Phoenix ICON wide-field infant fundus image; 1240 x 1240 pixels: 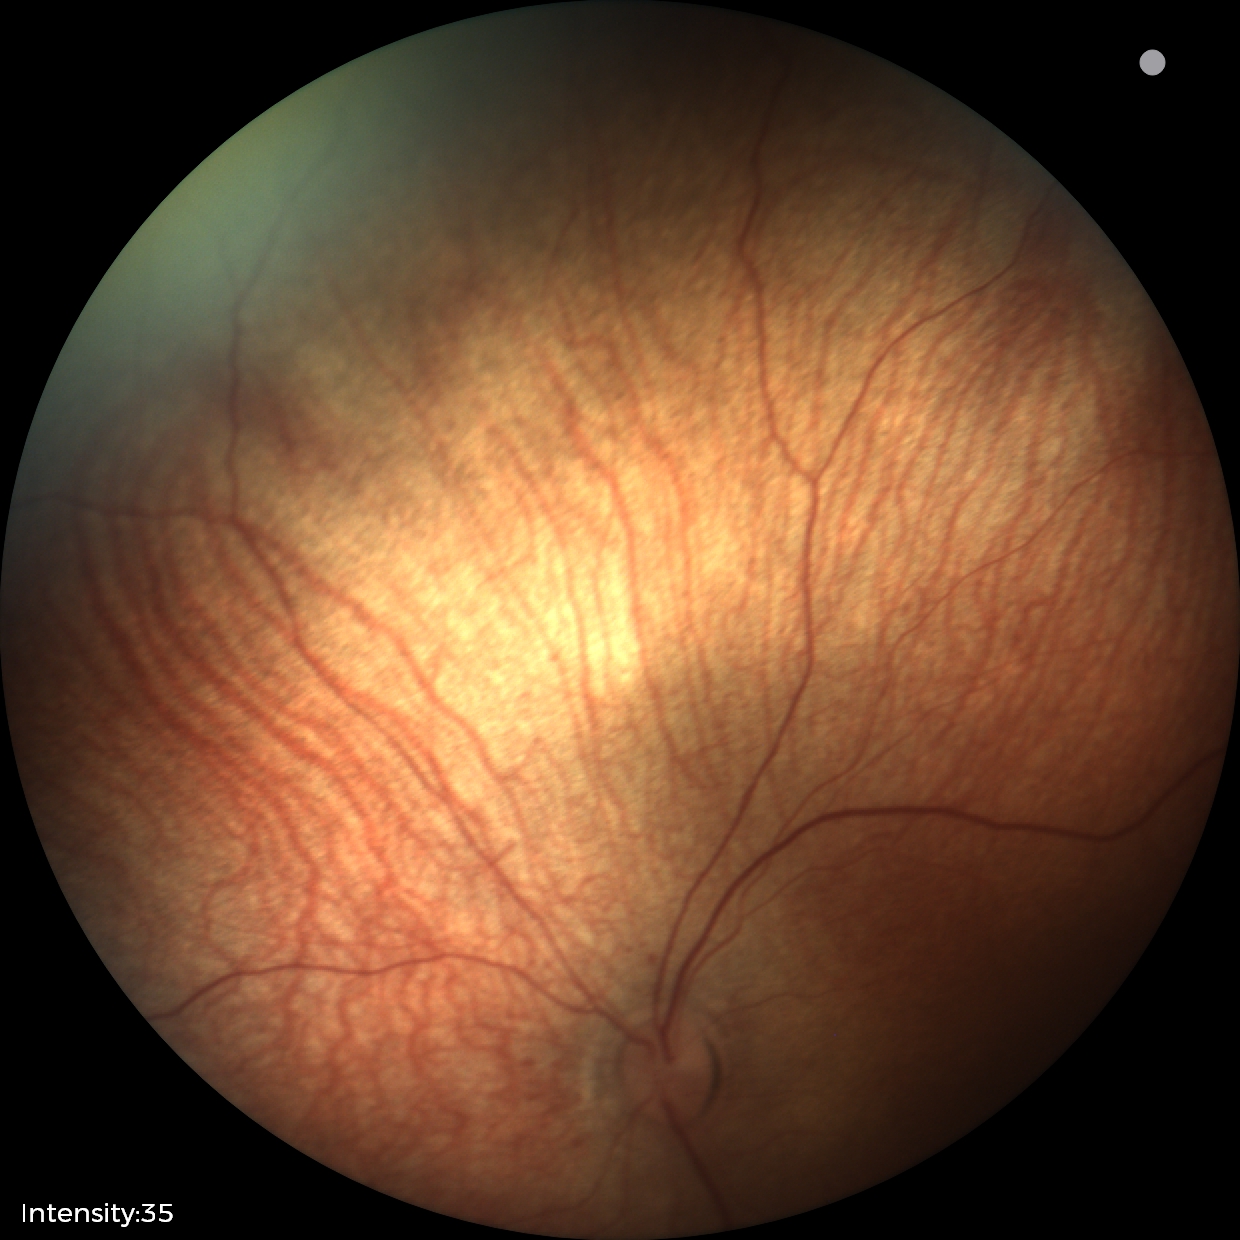 No retinal pathology identified on screening.